1440 x 1080 pixels; wide-field contact fundus photograph of an infant — 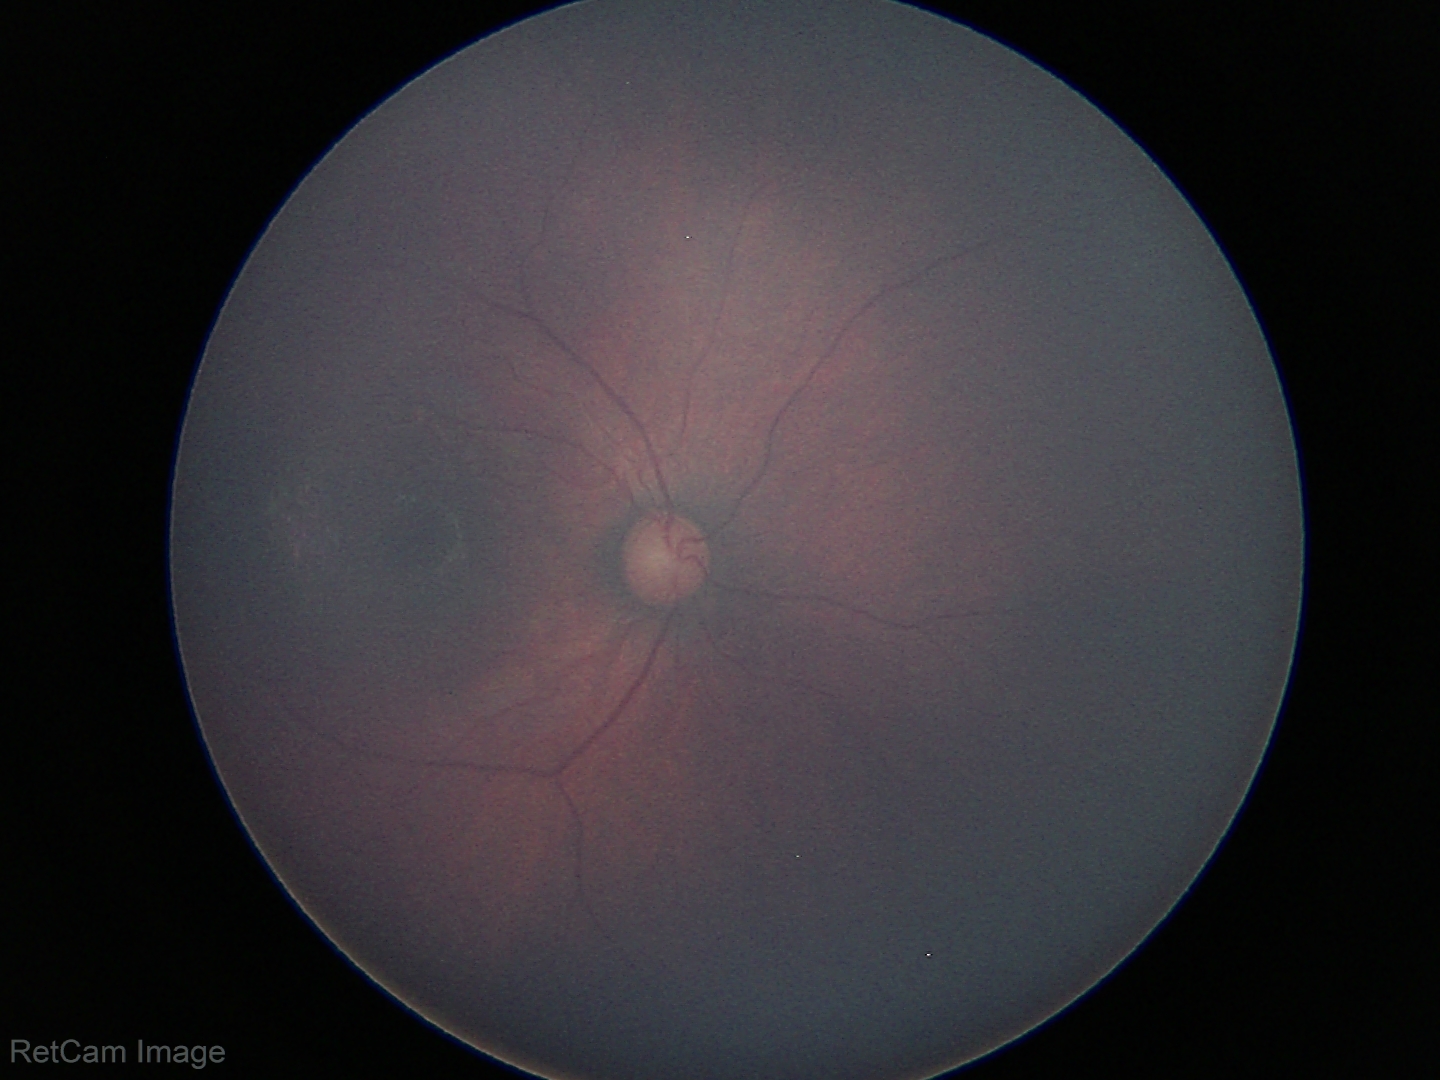 Normal screening examination.